200° FOV, ultra-widefield fundus mosaic.
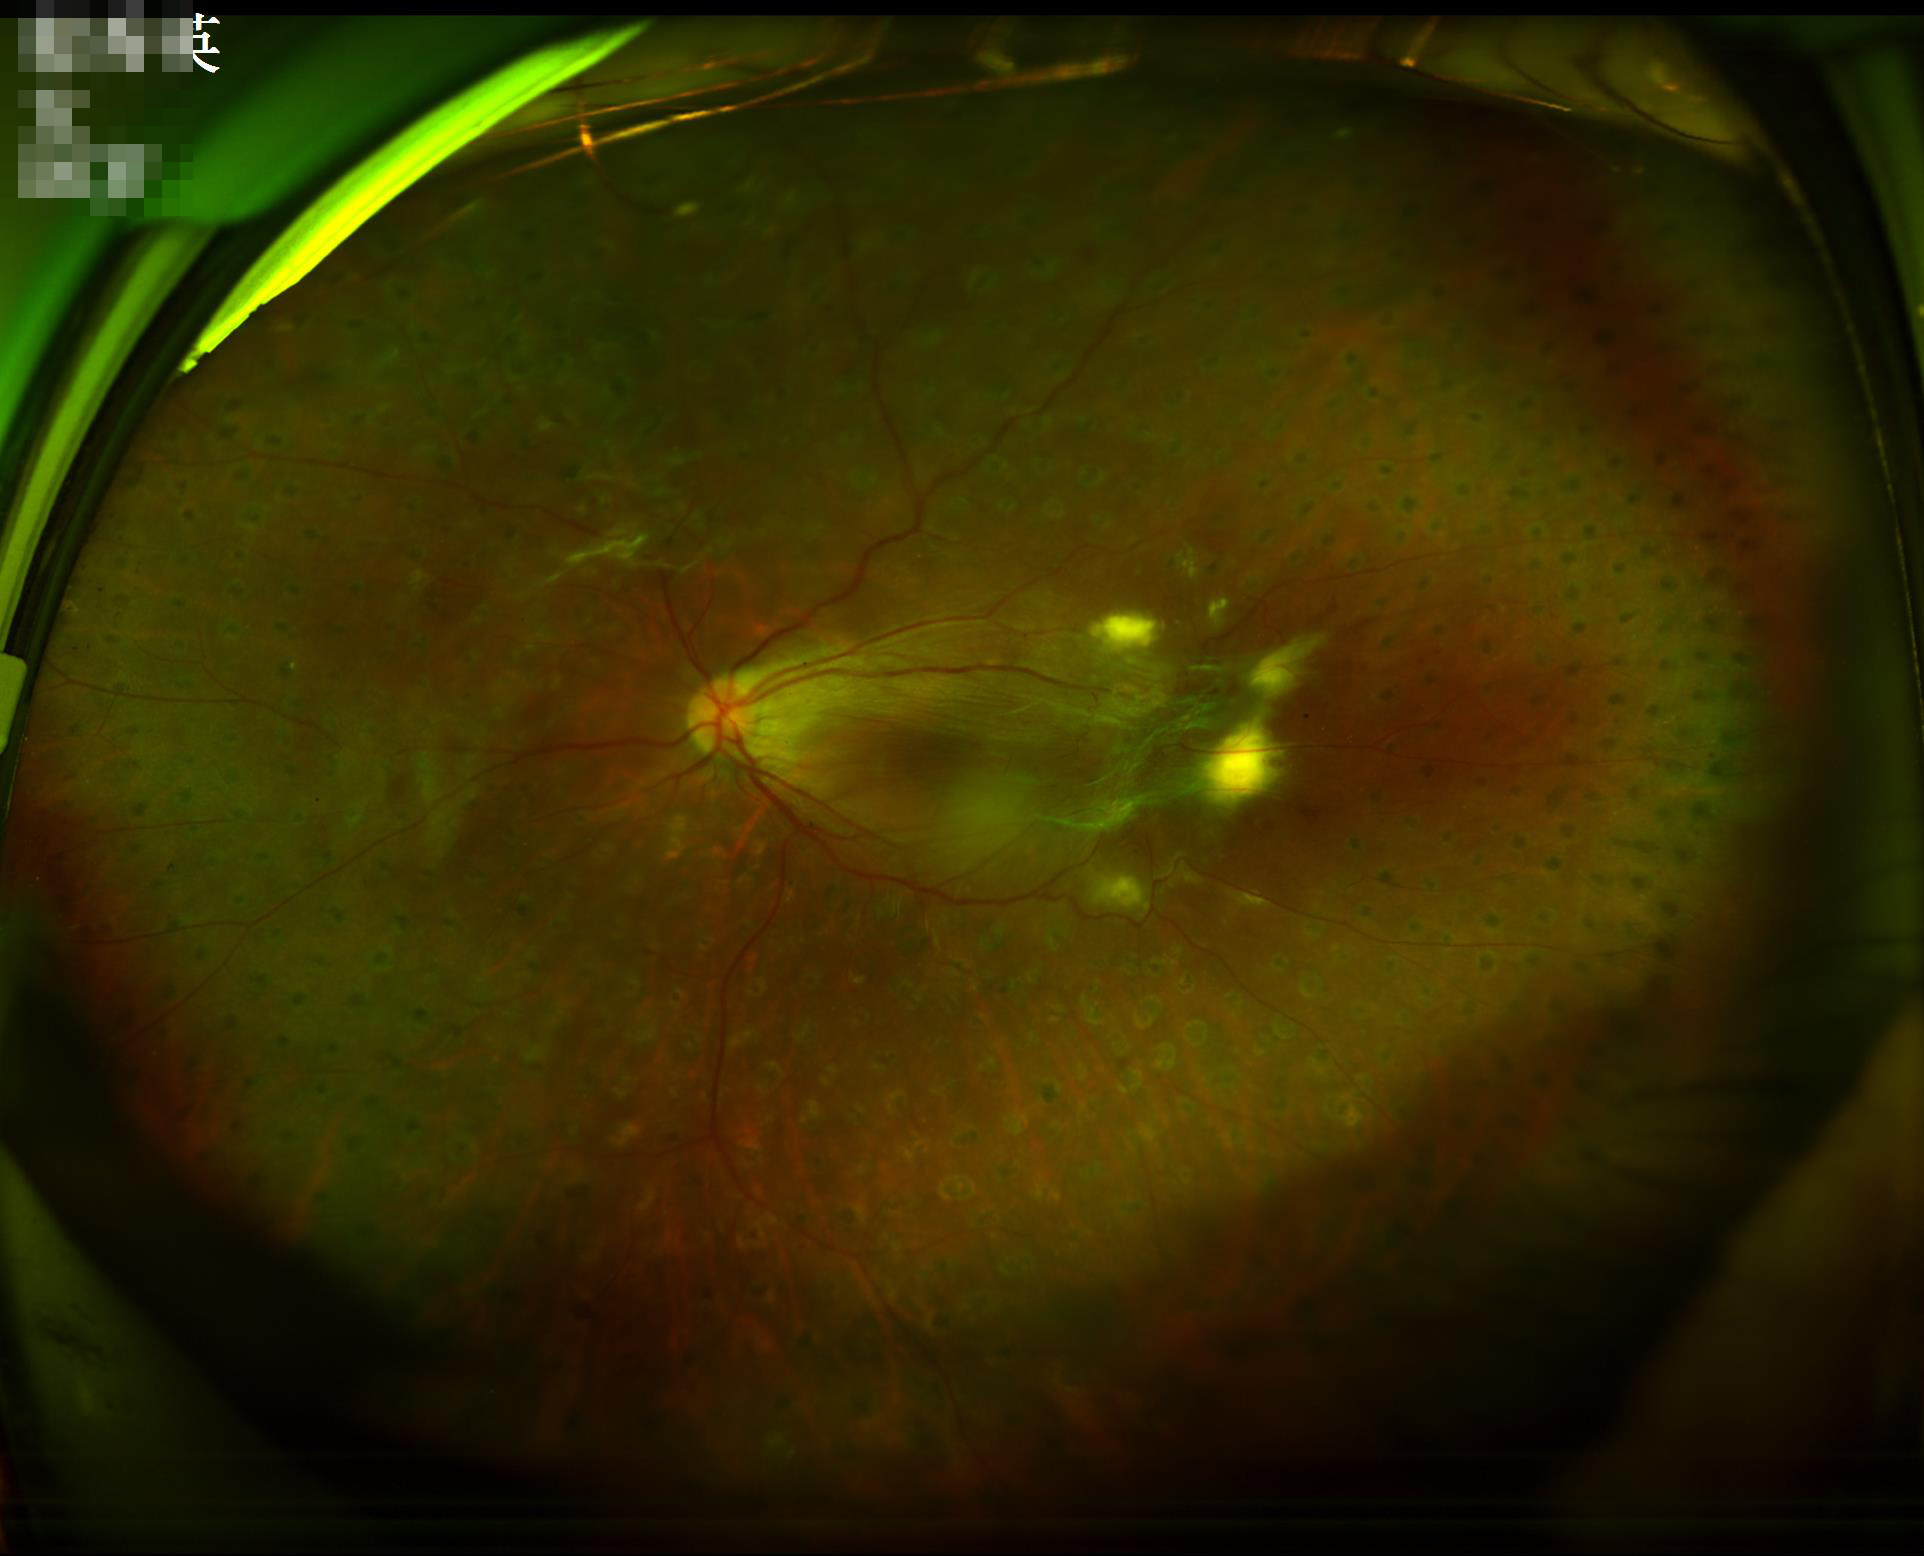

Contrast = adequate; Overall image quality = good; Sharpness = good; Illumination/color = suboptimal.